Camera: NIDEK AFC-230. Nonmydriatic fundus photograph. 45° field of view. Color fundus photograph. DR severity per modified Davis staging: 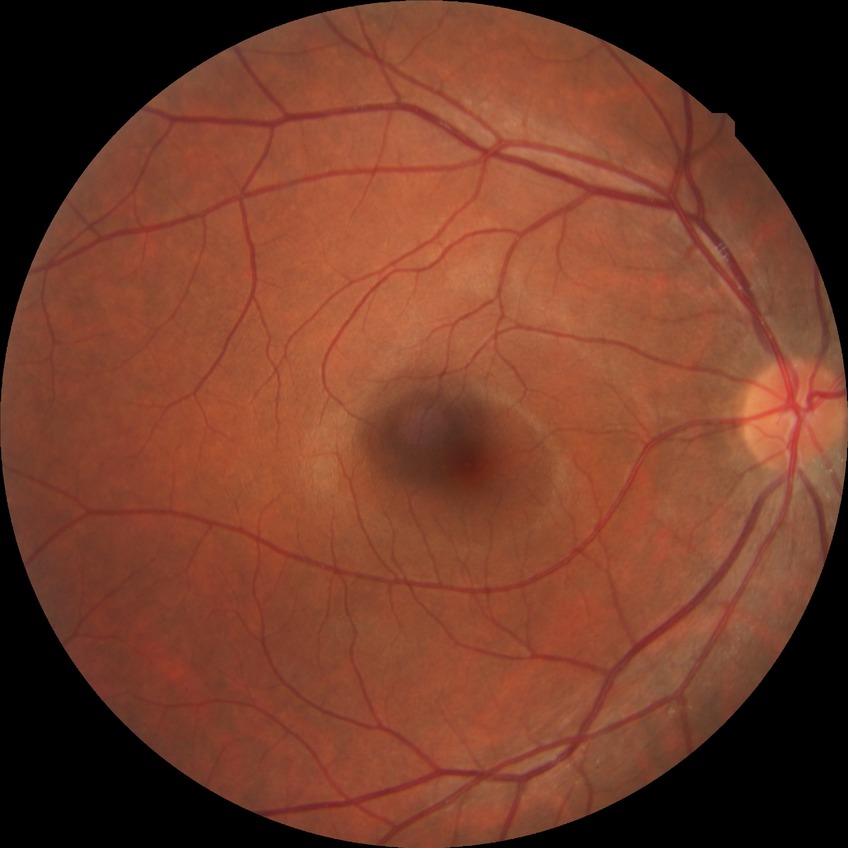 Modified Davis classification: no diabetic retinopathy.